Wide-field contact fundus photograph of an infant; captured with the Phoenix ICON (100° field of view) — 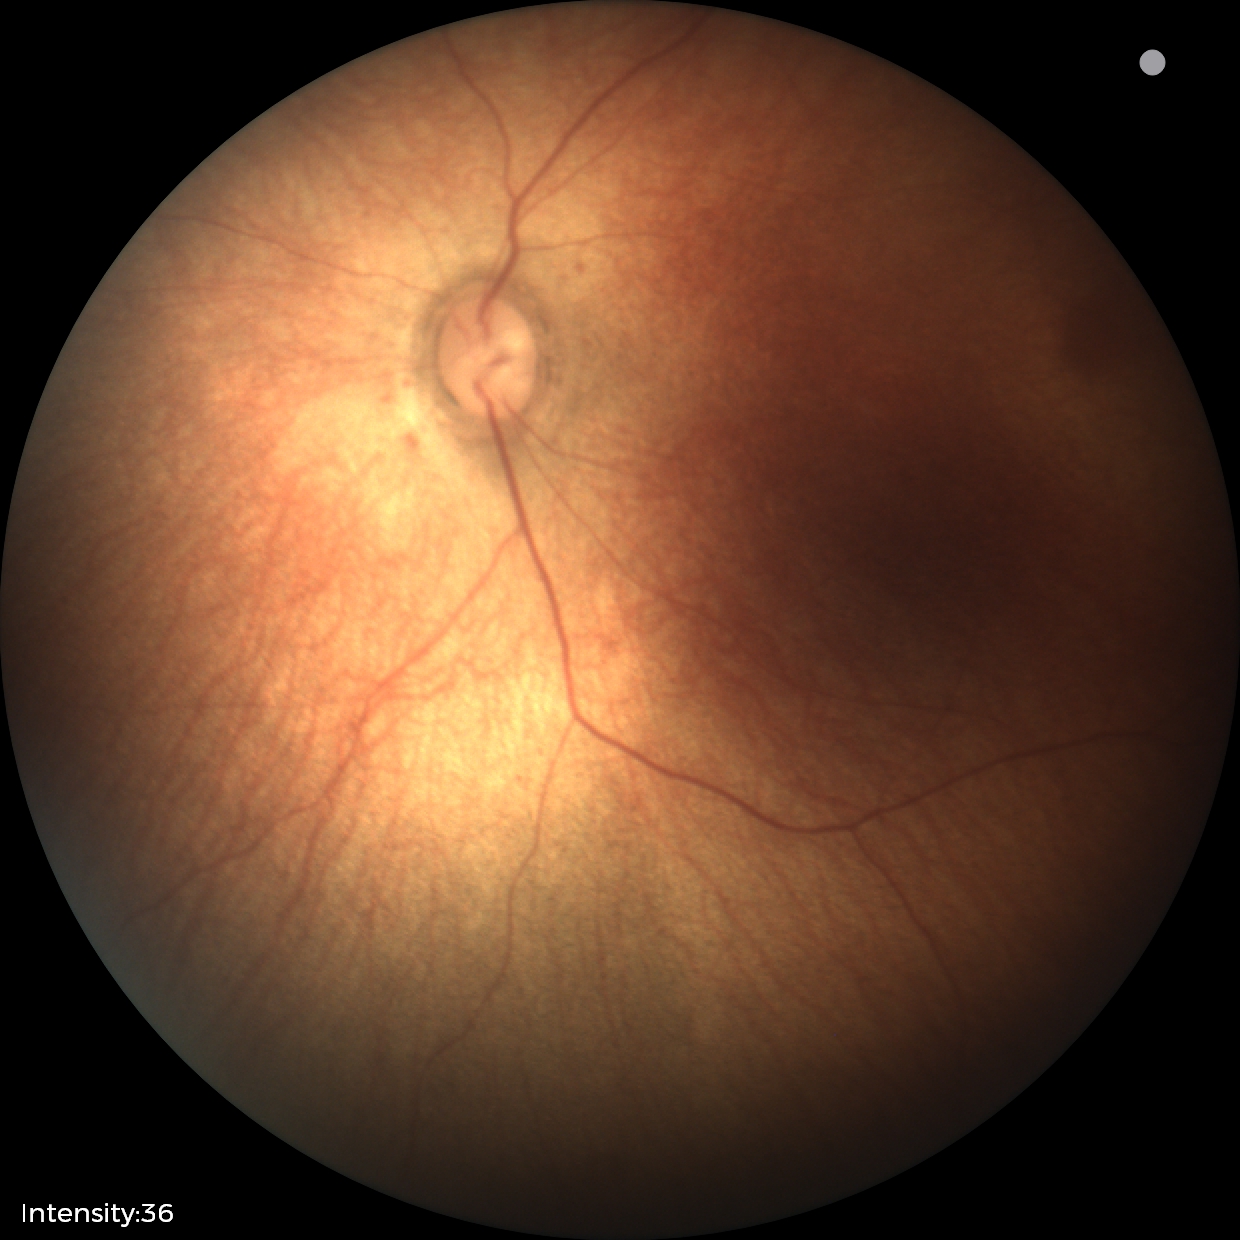 Impression: no abnormalities.